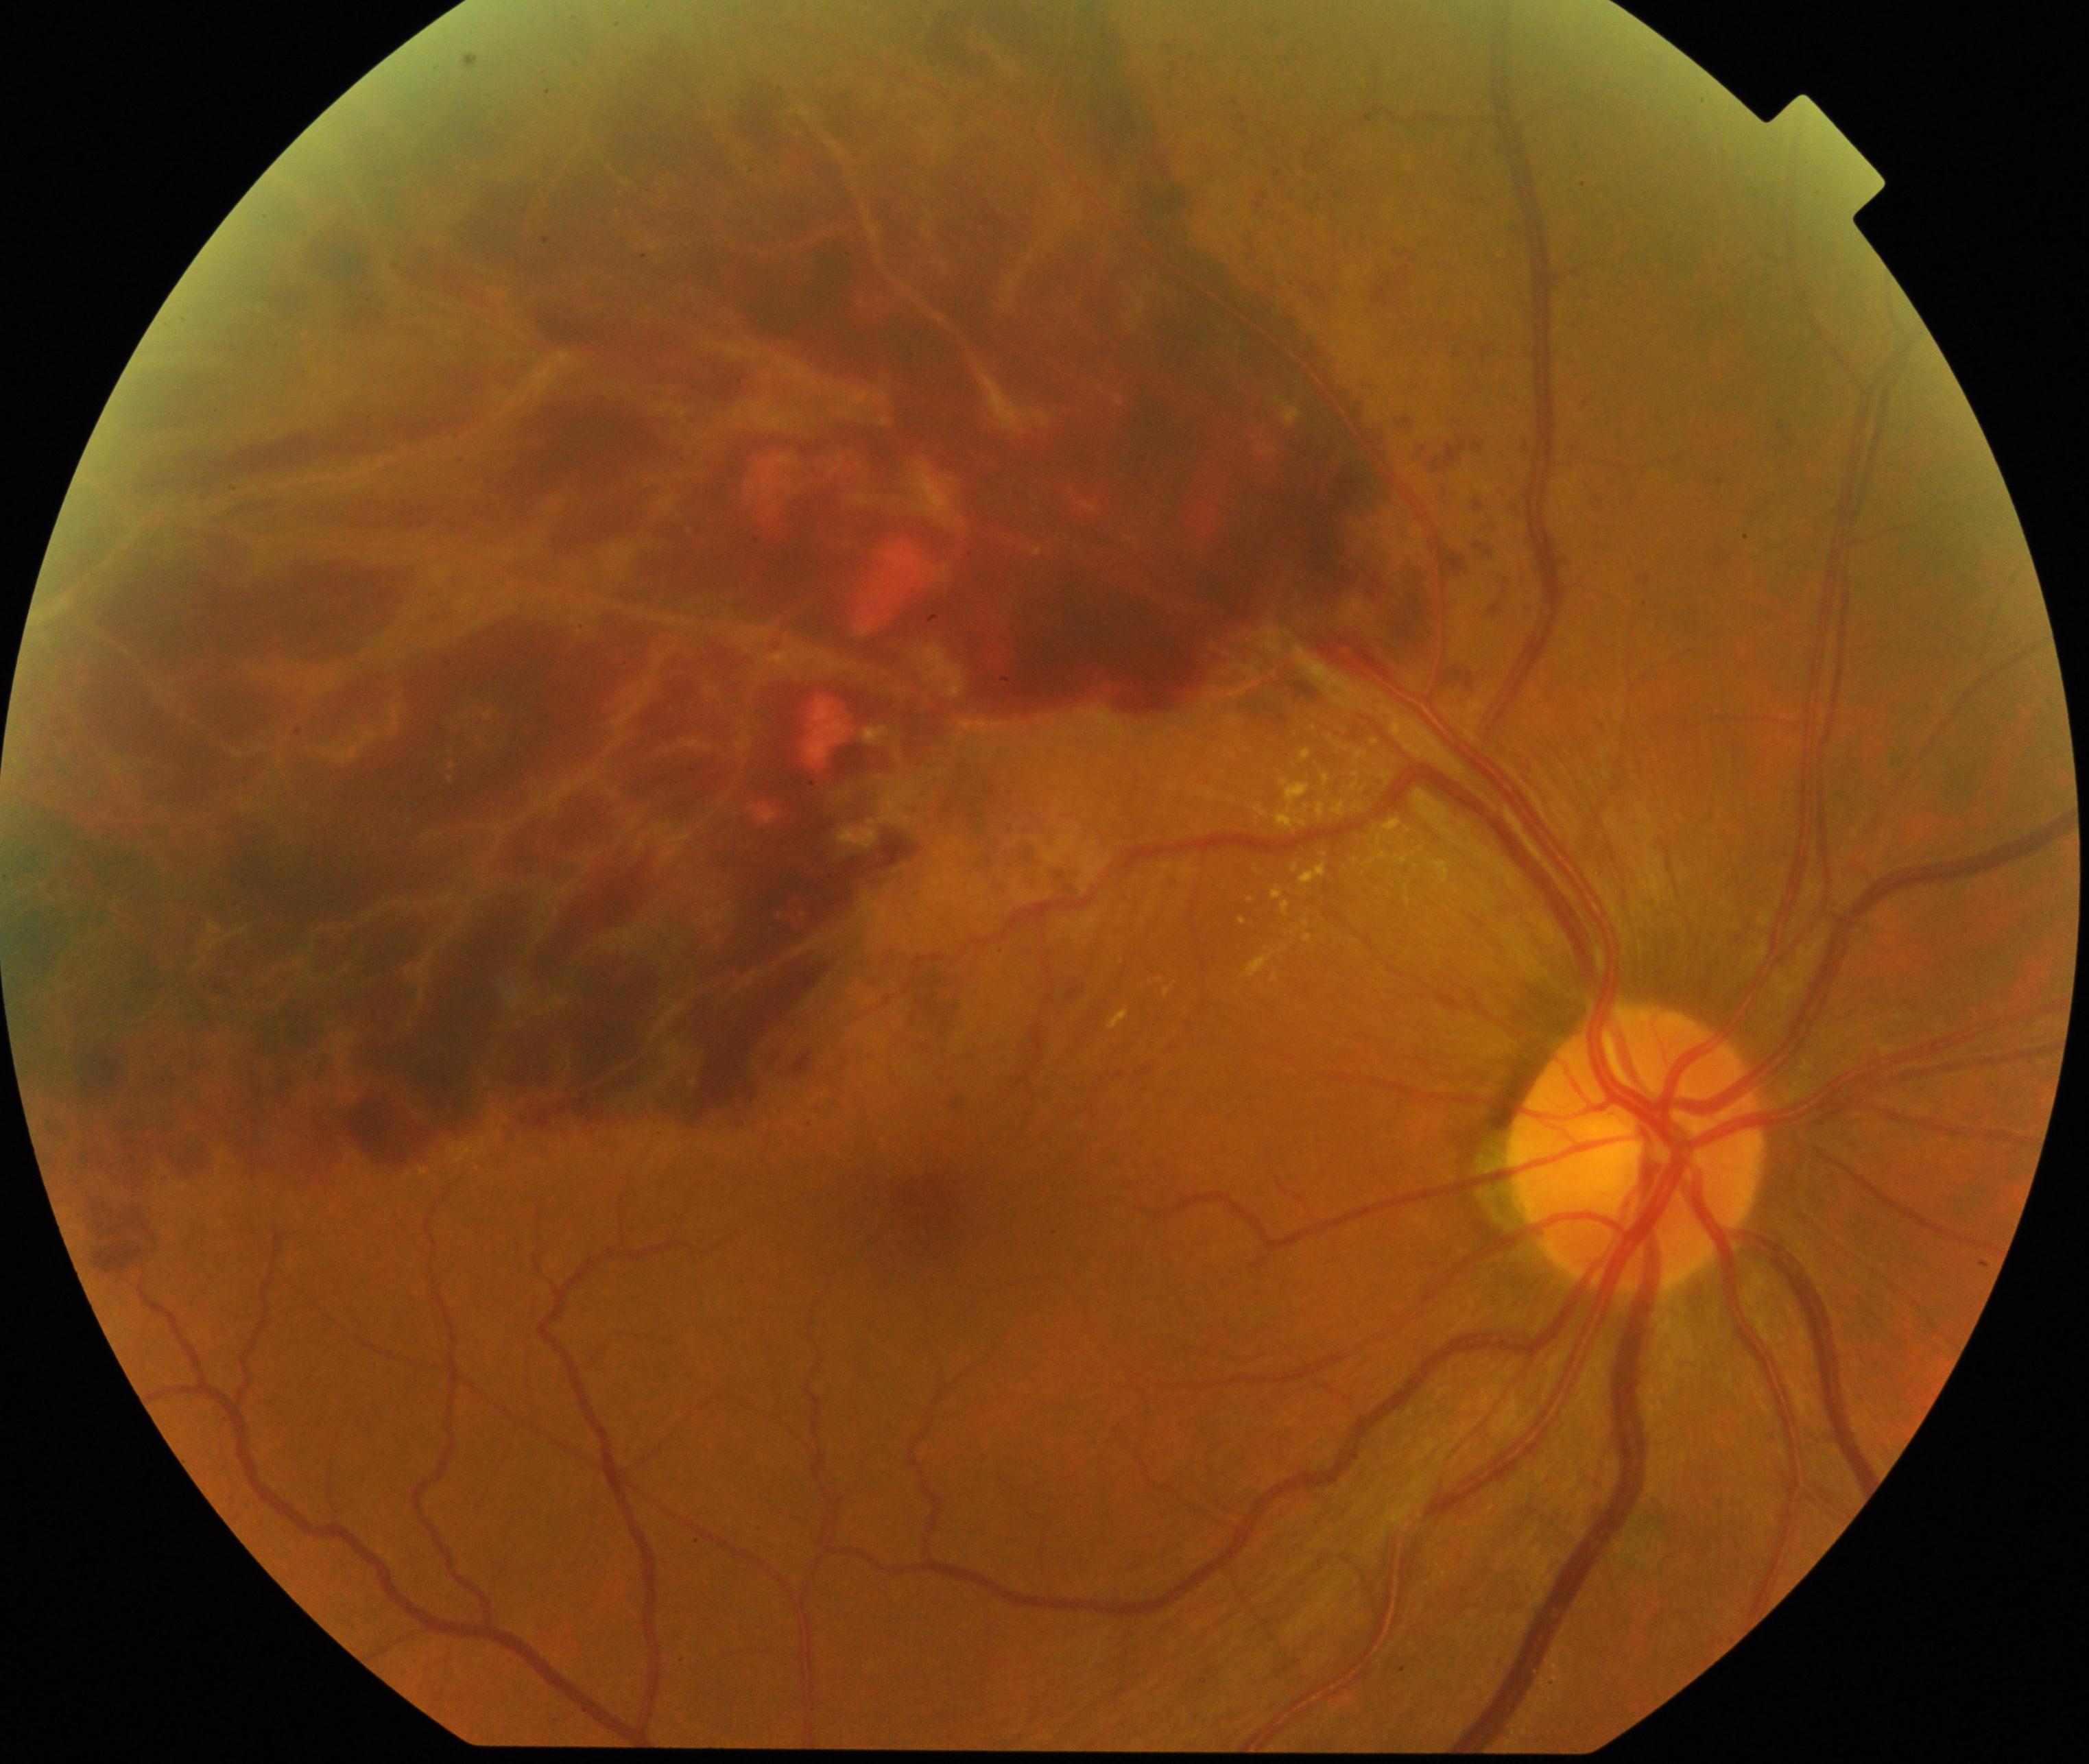

The image shows branch retinal vein occlusion (BRVO). Characterized by tortuosity and dilatation of affected veins, with dot, blot, and flame hemorrhages, sometimes with cotton-wool spots or hard exudates.